Camera: NIDEK AFC-230: 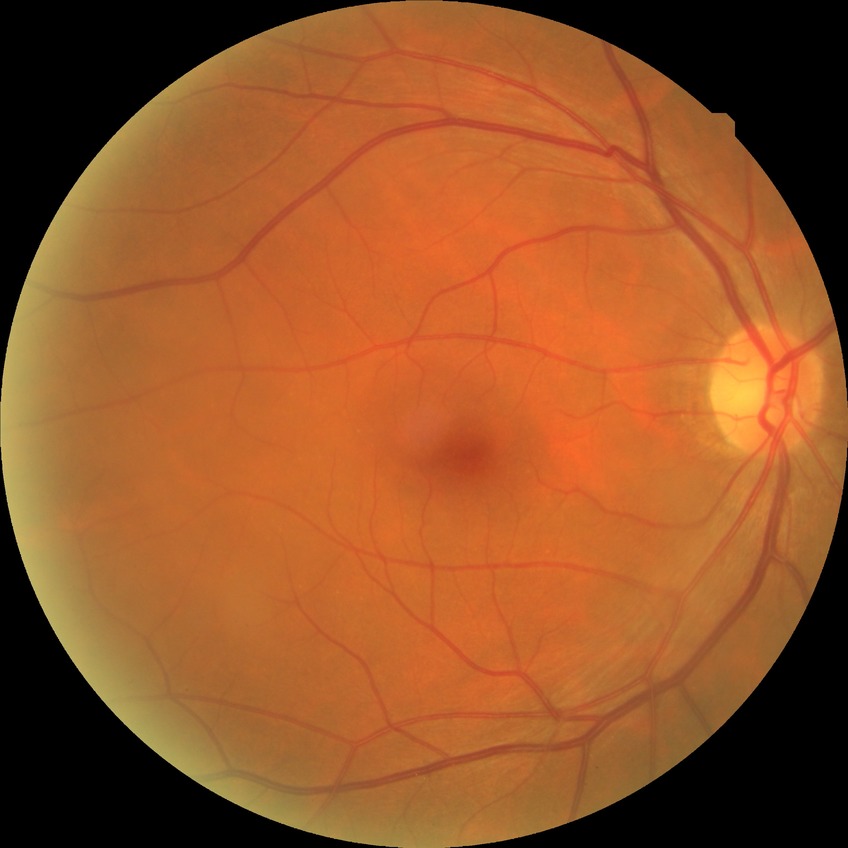 davis_grade: NDR
dr_impression: no apparent DR